Fundus photo; 2352 x 1568 pixels
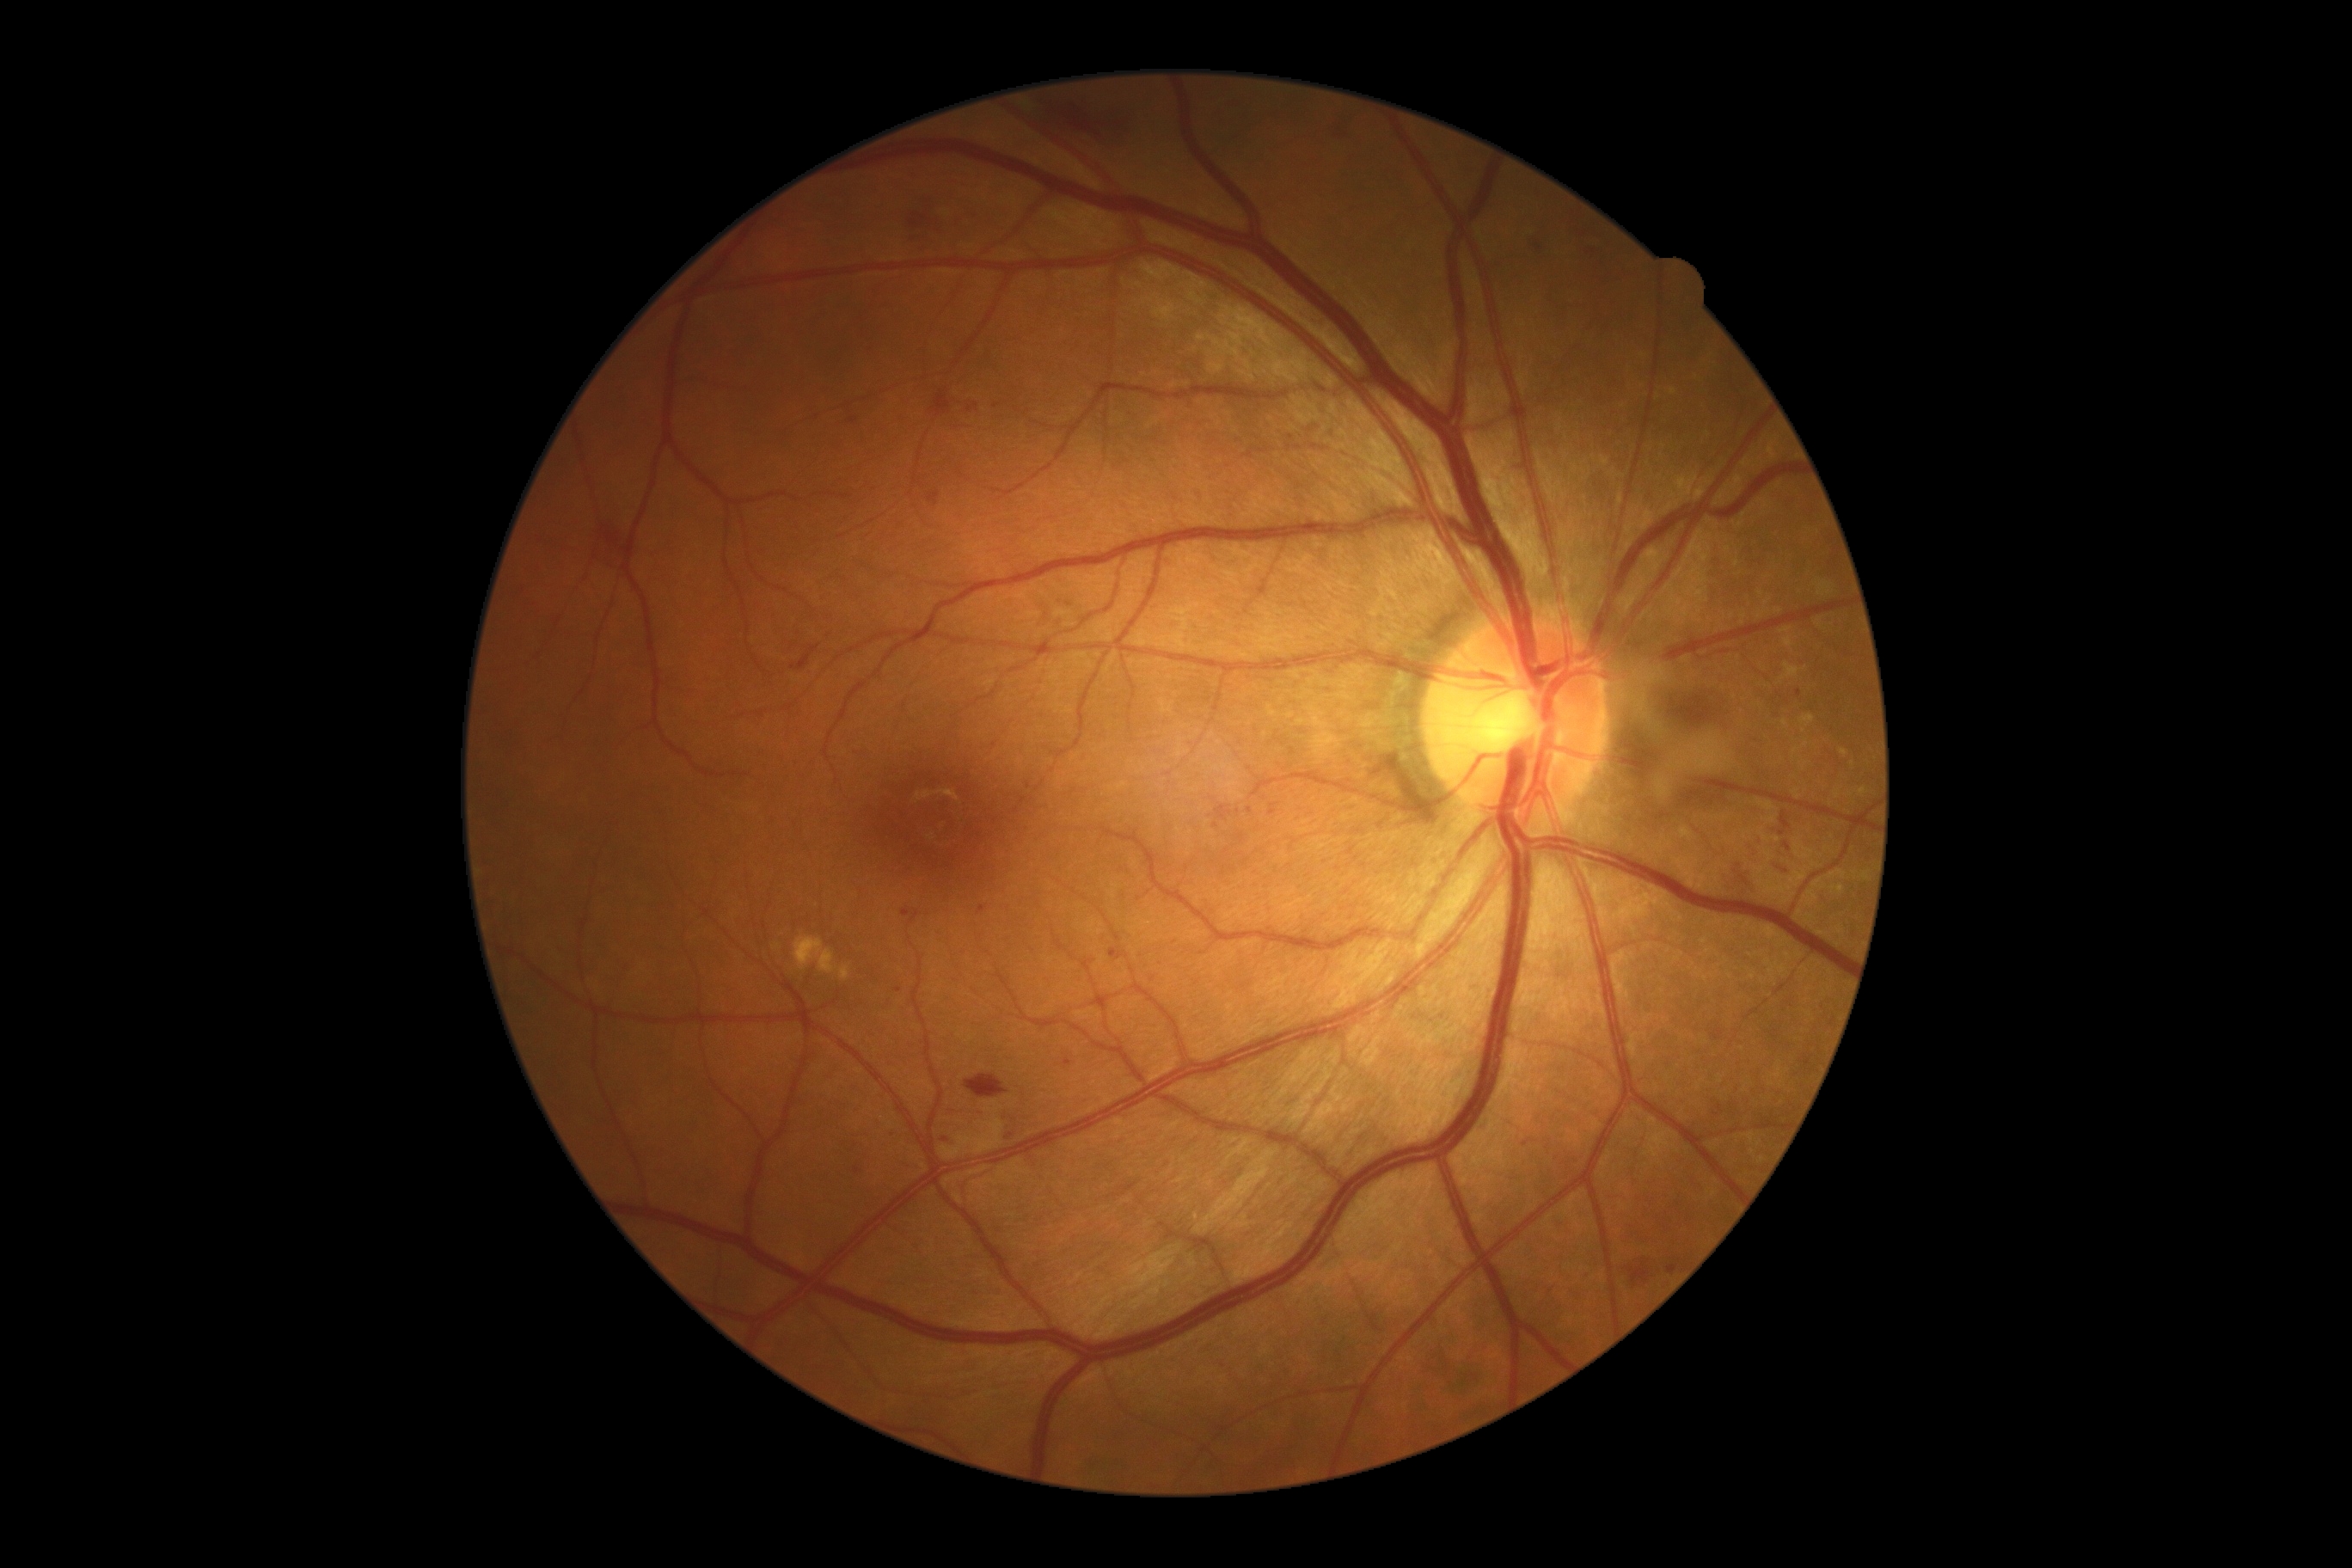

Retinopathy grade is moderate NPDR (2) — more than just microaneurysms but less than severe NPDR.
No hard exudates identified.
No soft exudates identified.
No microaneurysms identified.
Hemorrhages (partial list) at <box>1008,95,1146,147</box>; <box>977,907,986,916</box>; <box>965,1075,1008,1099</box>; <box>599,524,630,570</box>; <box>1005,1122,1024,1144</box>; <box>1270,805,1277,816</box>; <box>792,646,821,671</box>; <box>1522,1139,1534,1148</box>; <box>1772,864,1792,878</box>; <box>1020,797,1027,805</box>; <box>1646,683,1729,733</box>; <box>1306,424,1320,438</box>; <box>1325,429,1335,438</box>; <box>847,412,859,426</box>; <box>1108,948,1129,960</box>; <box>1779,811,1792,836</box>.
Hemorrhages (small, approximate centers) near point(1017, 811); point(1799, 693); point(945, 1139); point(898, 991).